Infant wide-field retinal image: 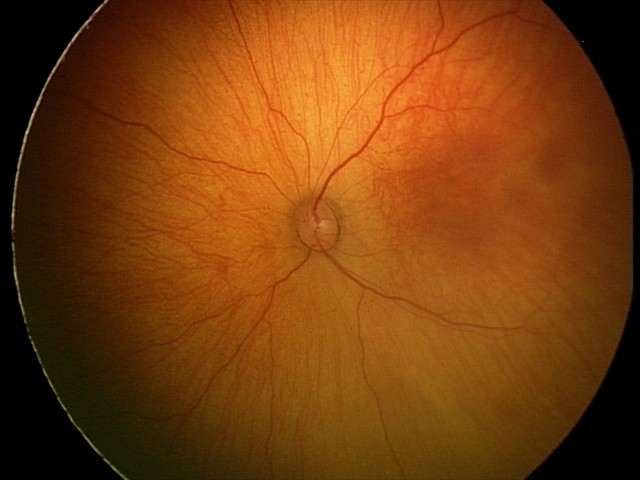 Screening examination with no abnormal retinal findings.